Wide-field fundus photograph from neonatal ROP screening; 100° field of view (Phoenix ICON)
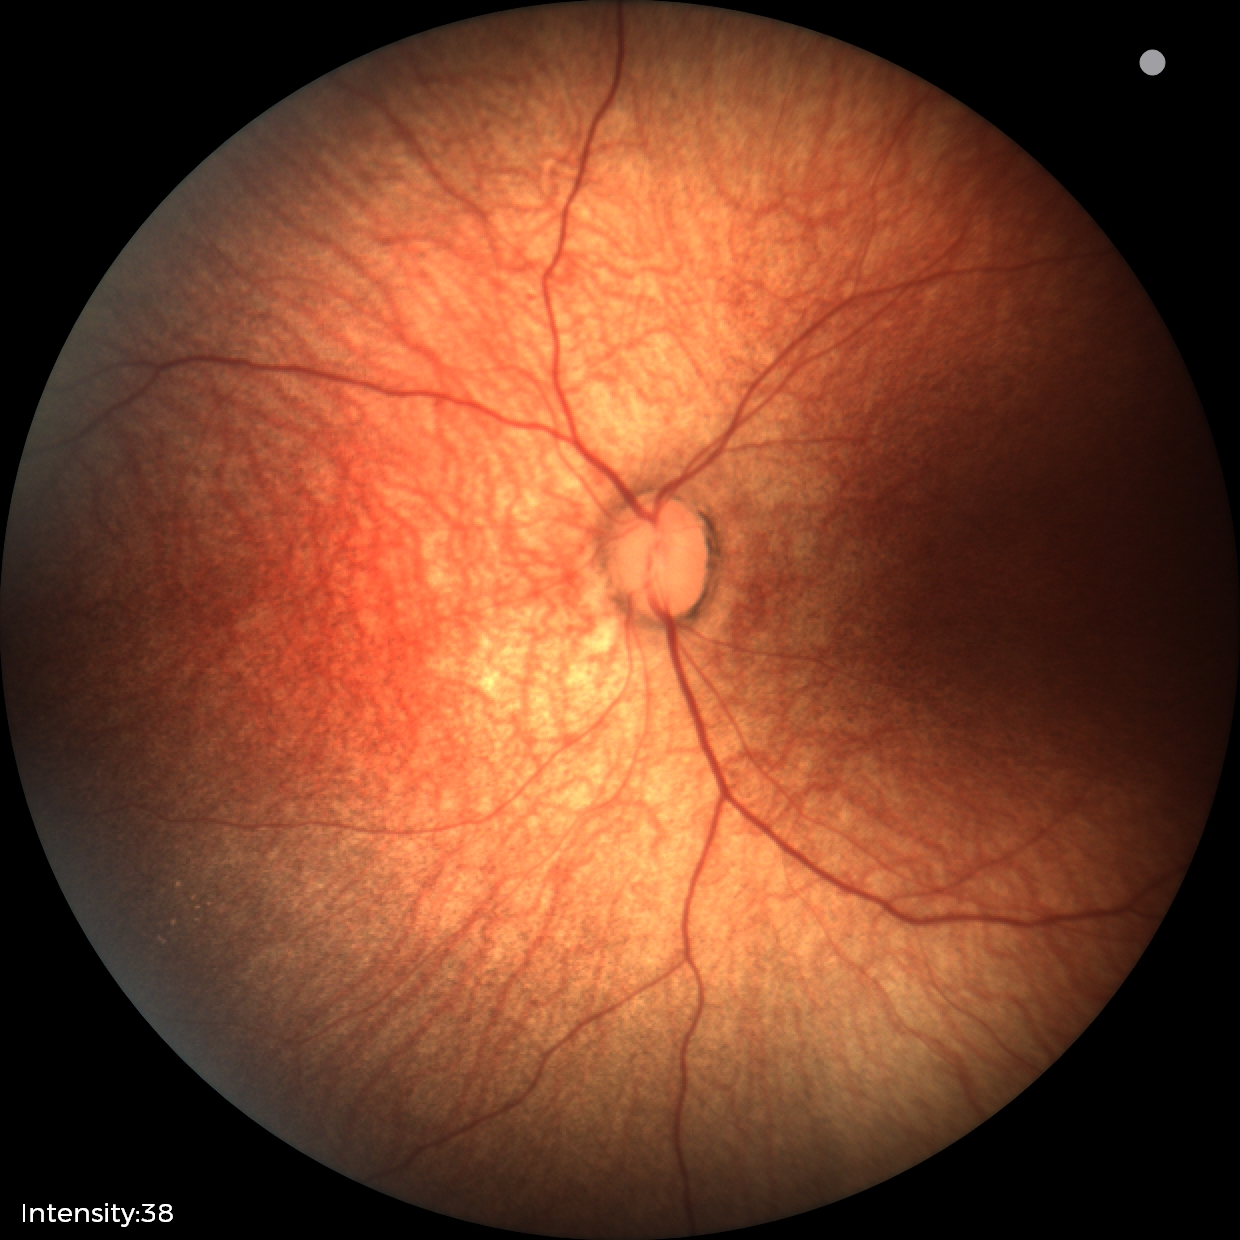

Examination with physiological retinal findings.